Color fundus photograph: 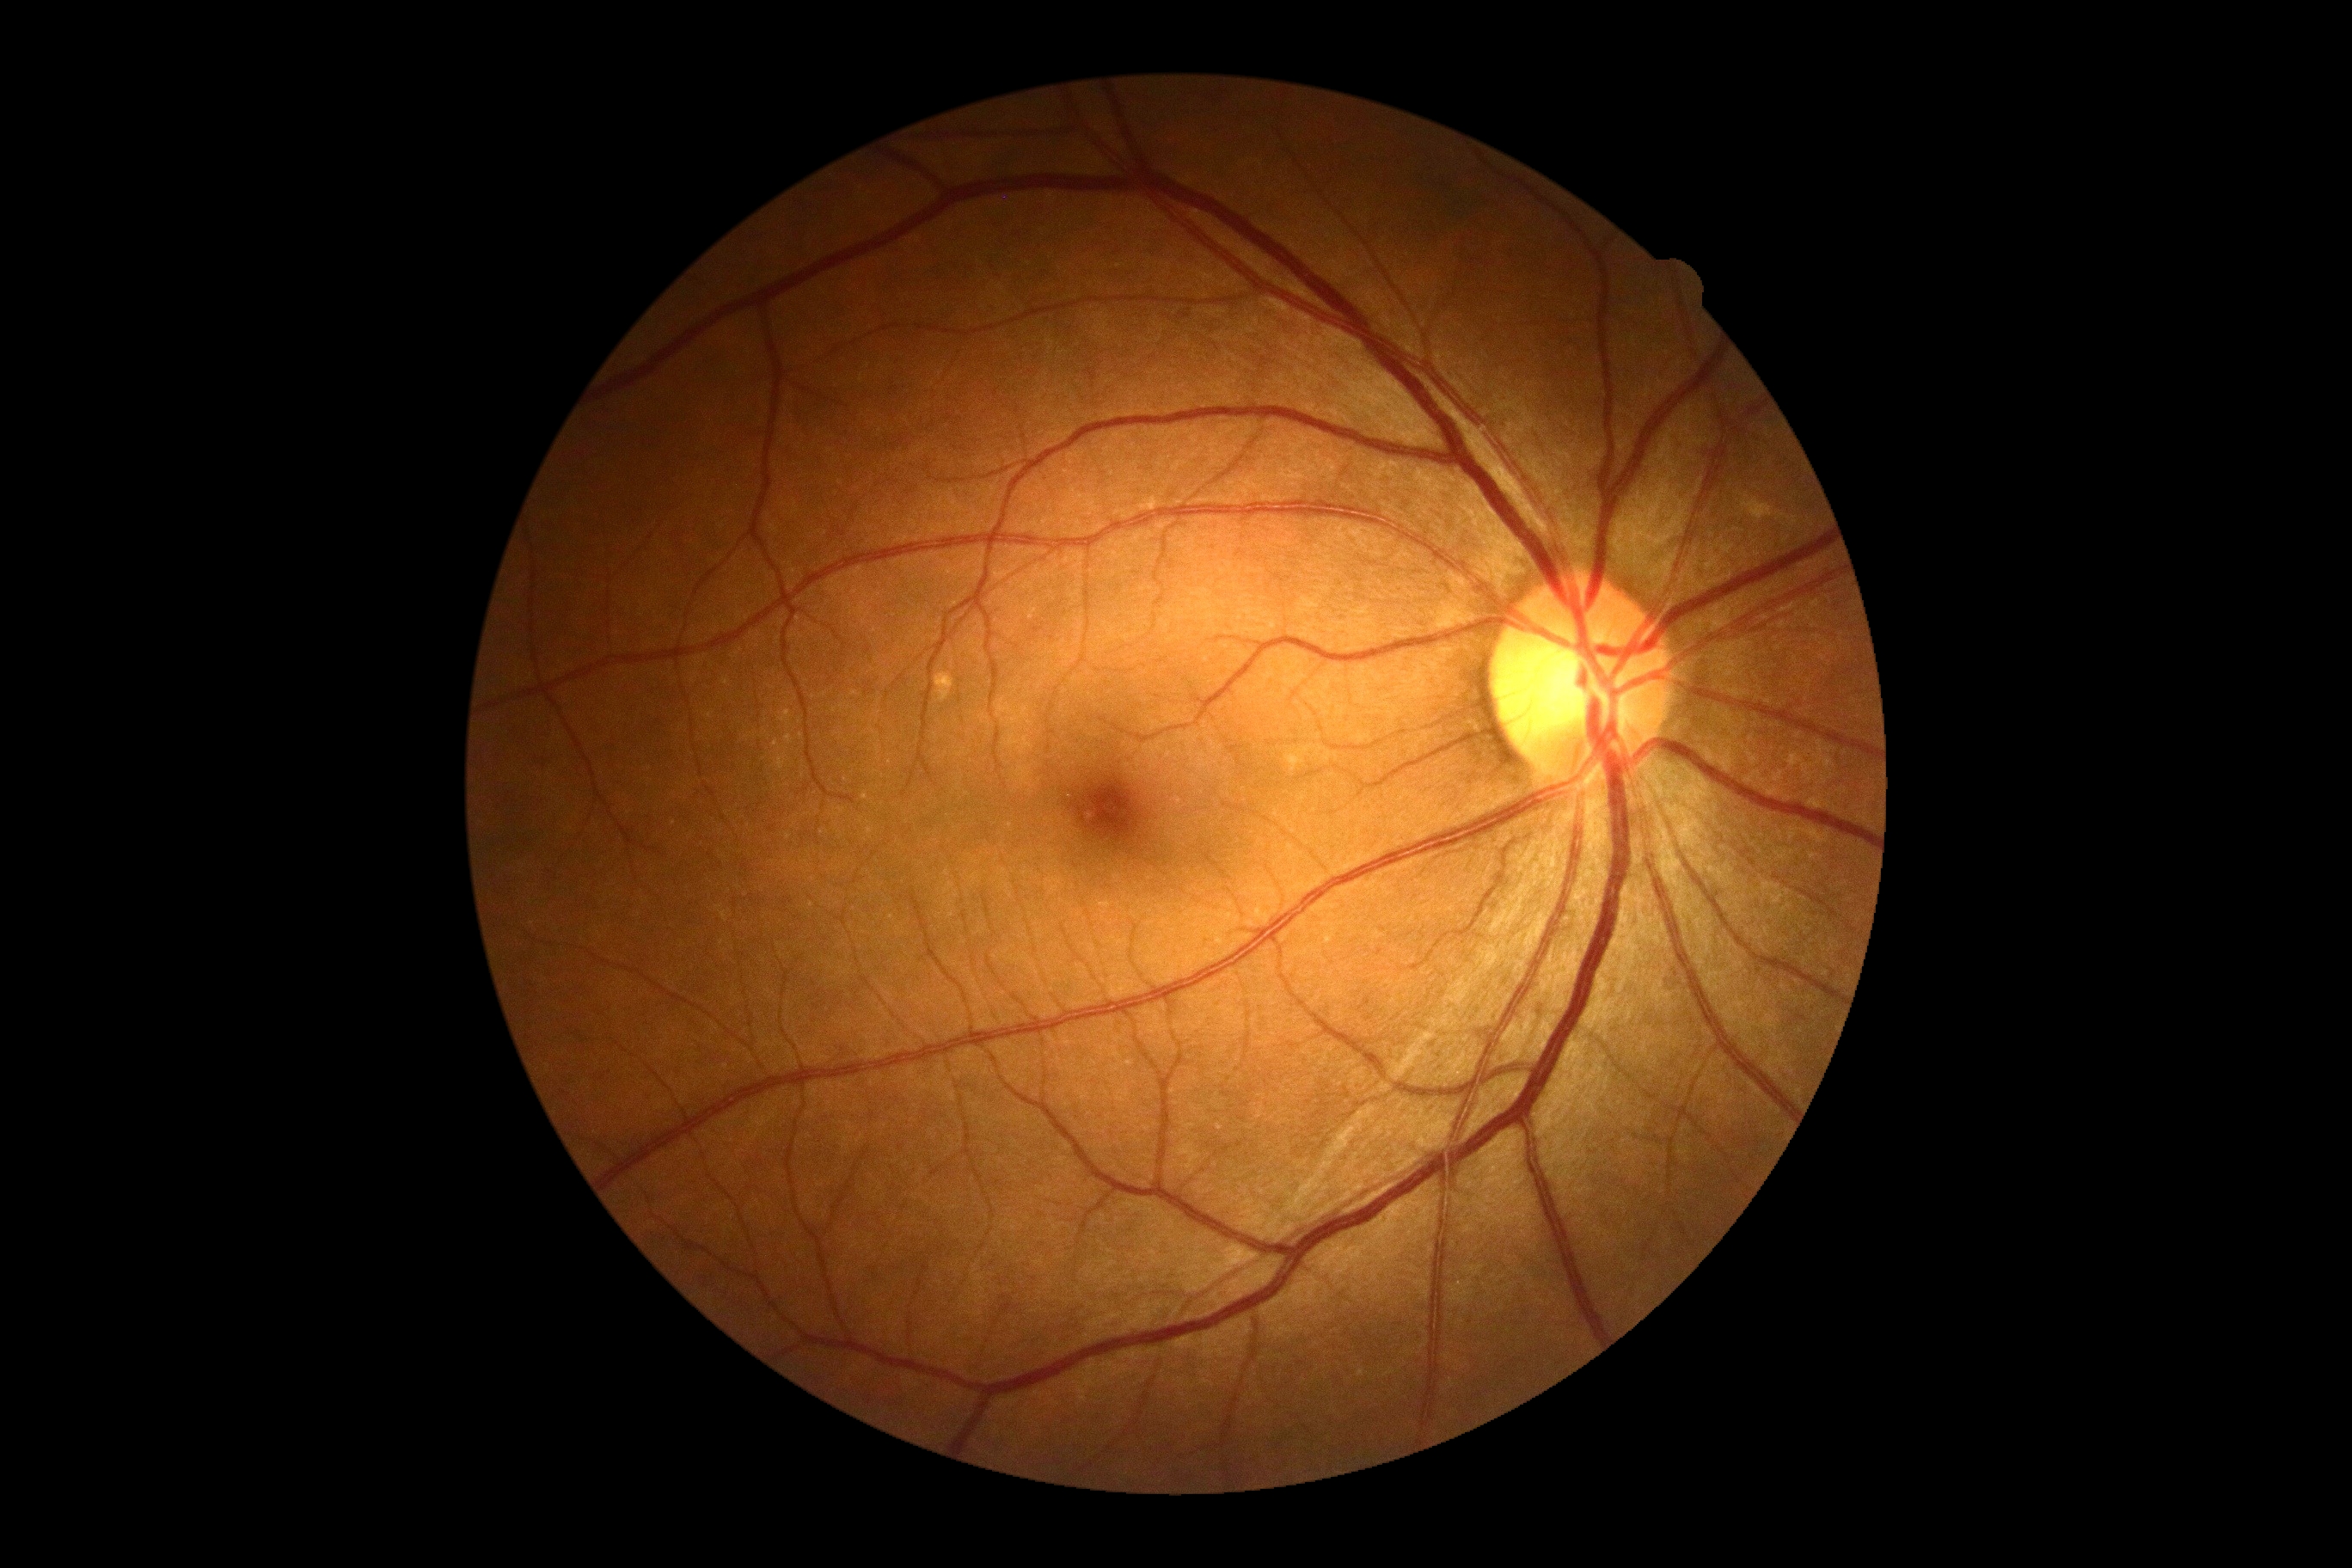 {"dr_grade": "grade 0 (no apparent retinopathy)", "dr_impression": "no DR findings"}